FOV: 45 degrees: 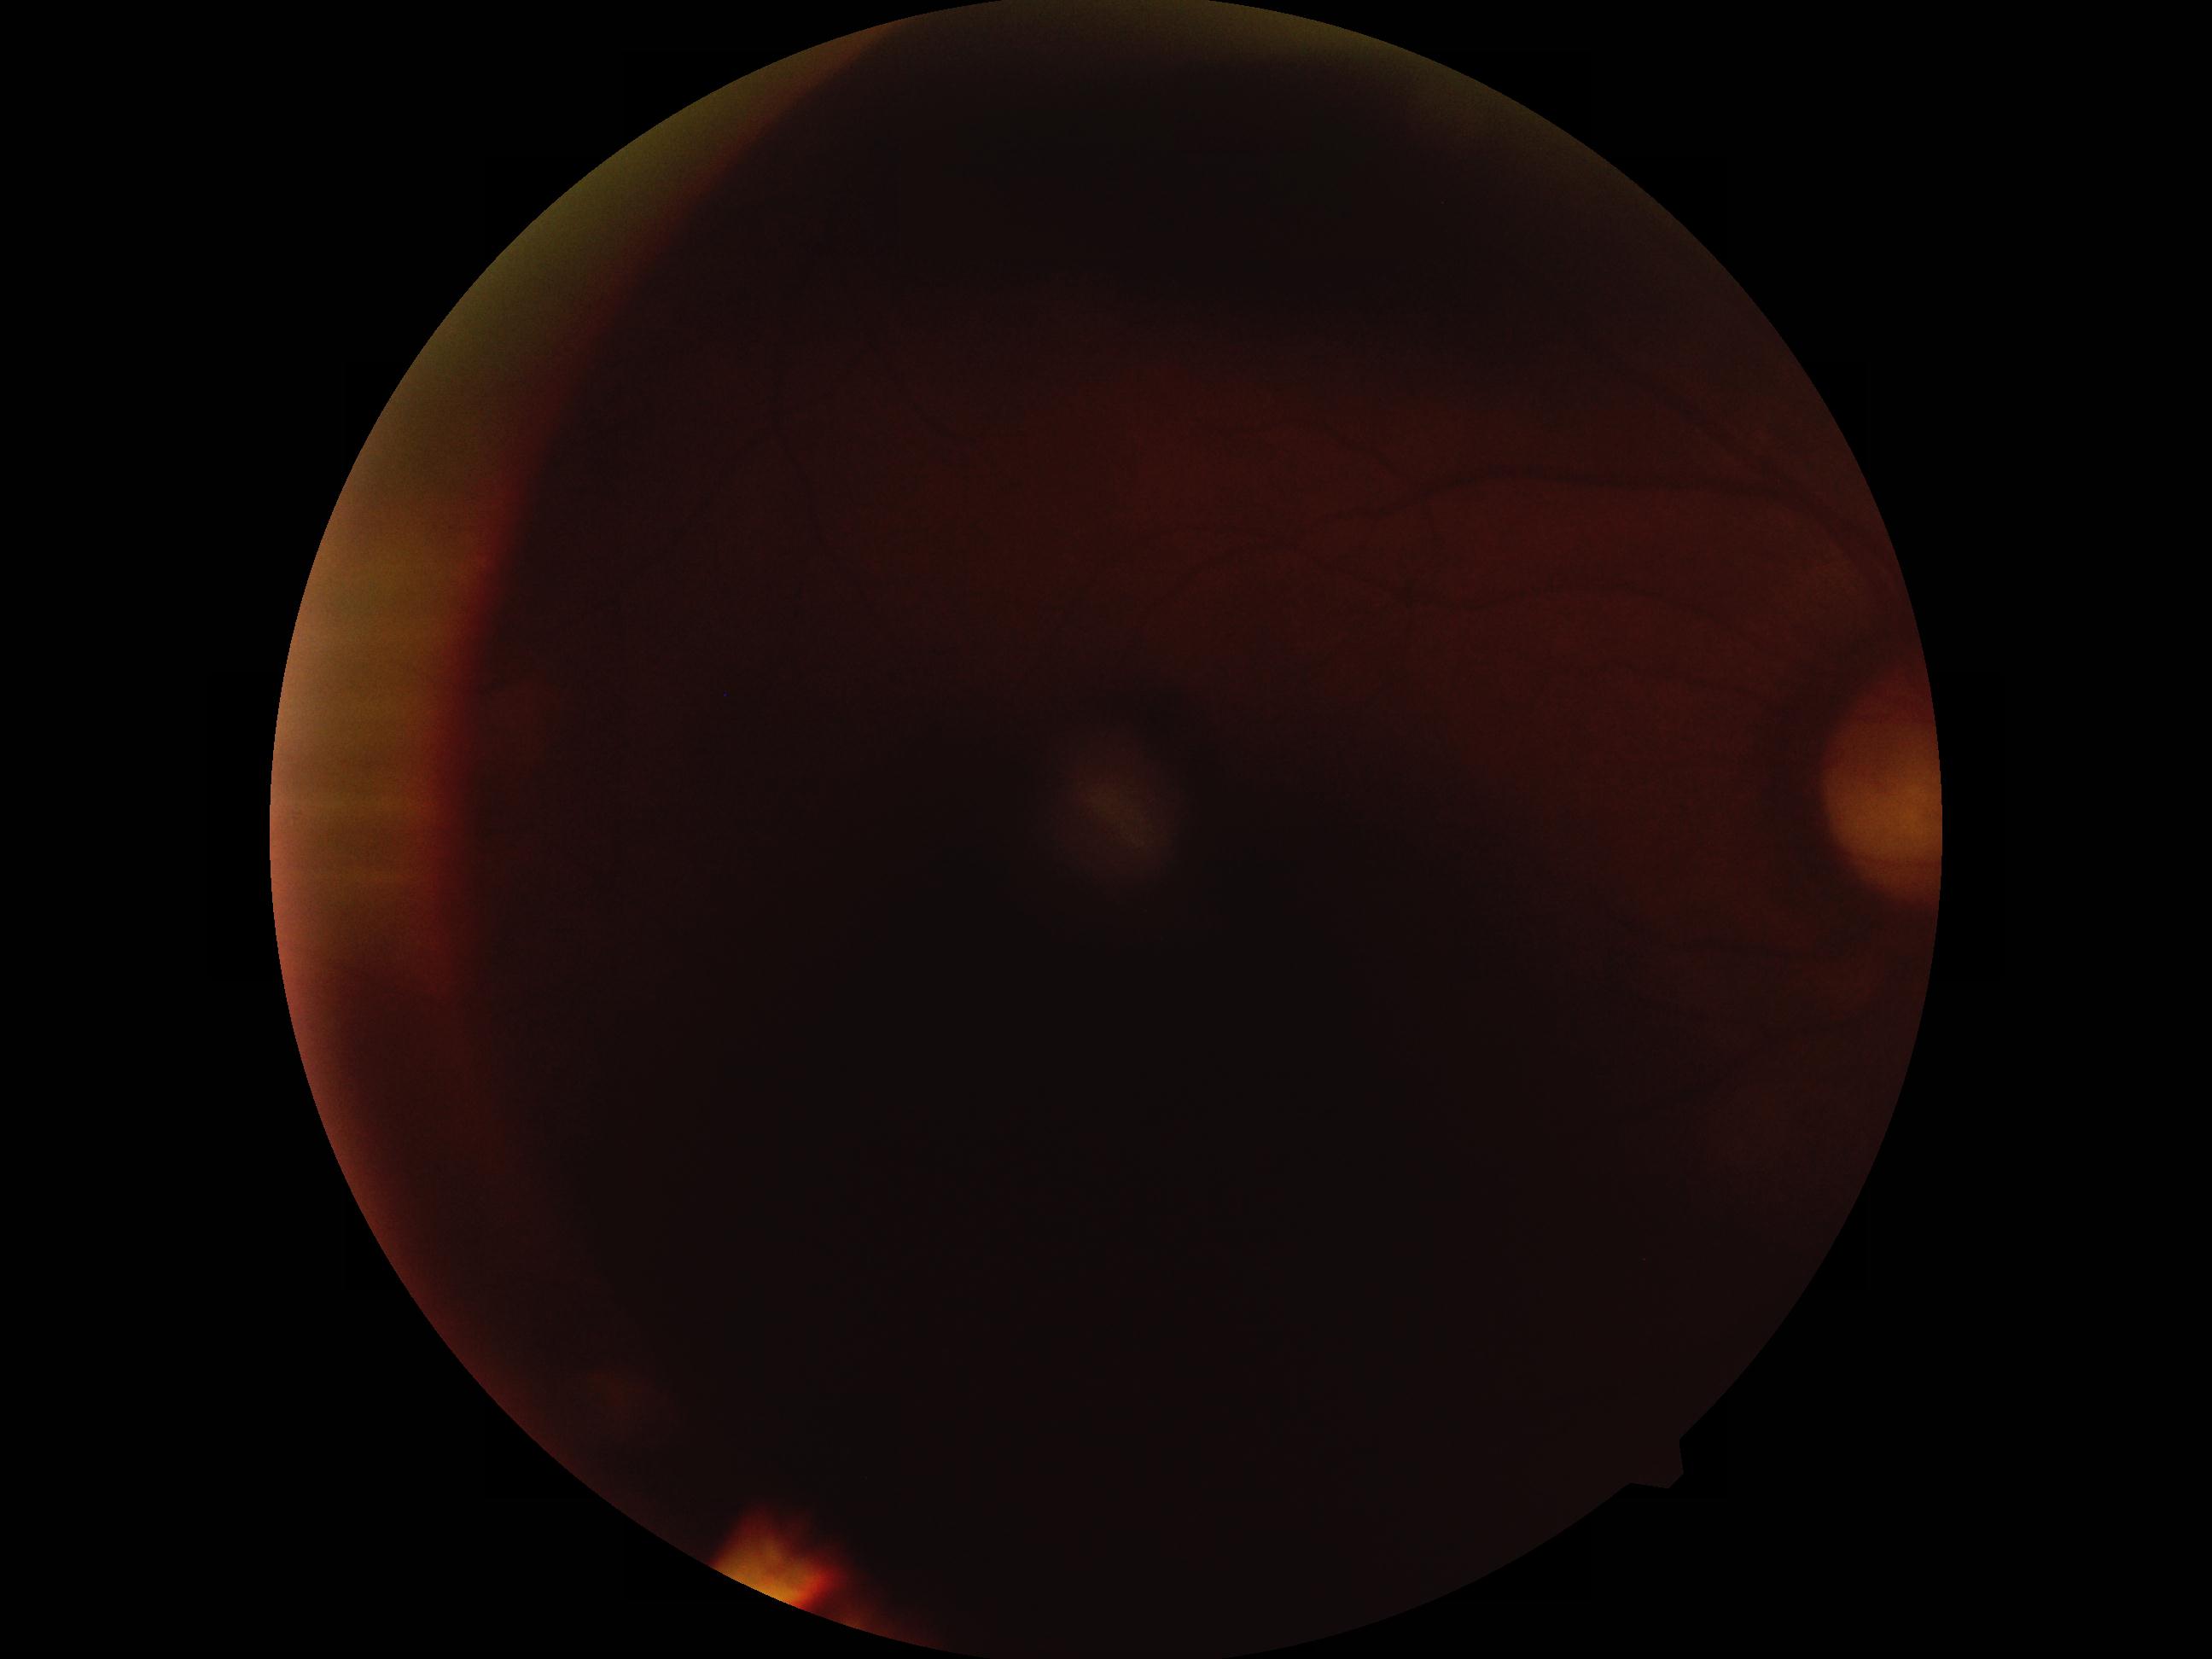

Diabetic retinopathy severity: ungradable. Image quality is insufficient for diabetic retinopathy assessment.